FOV: 45 degrees:
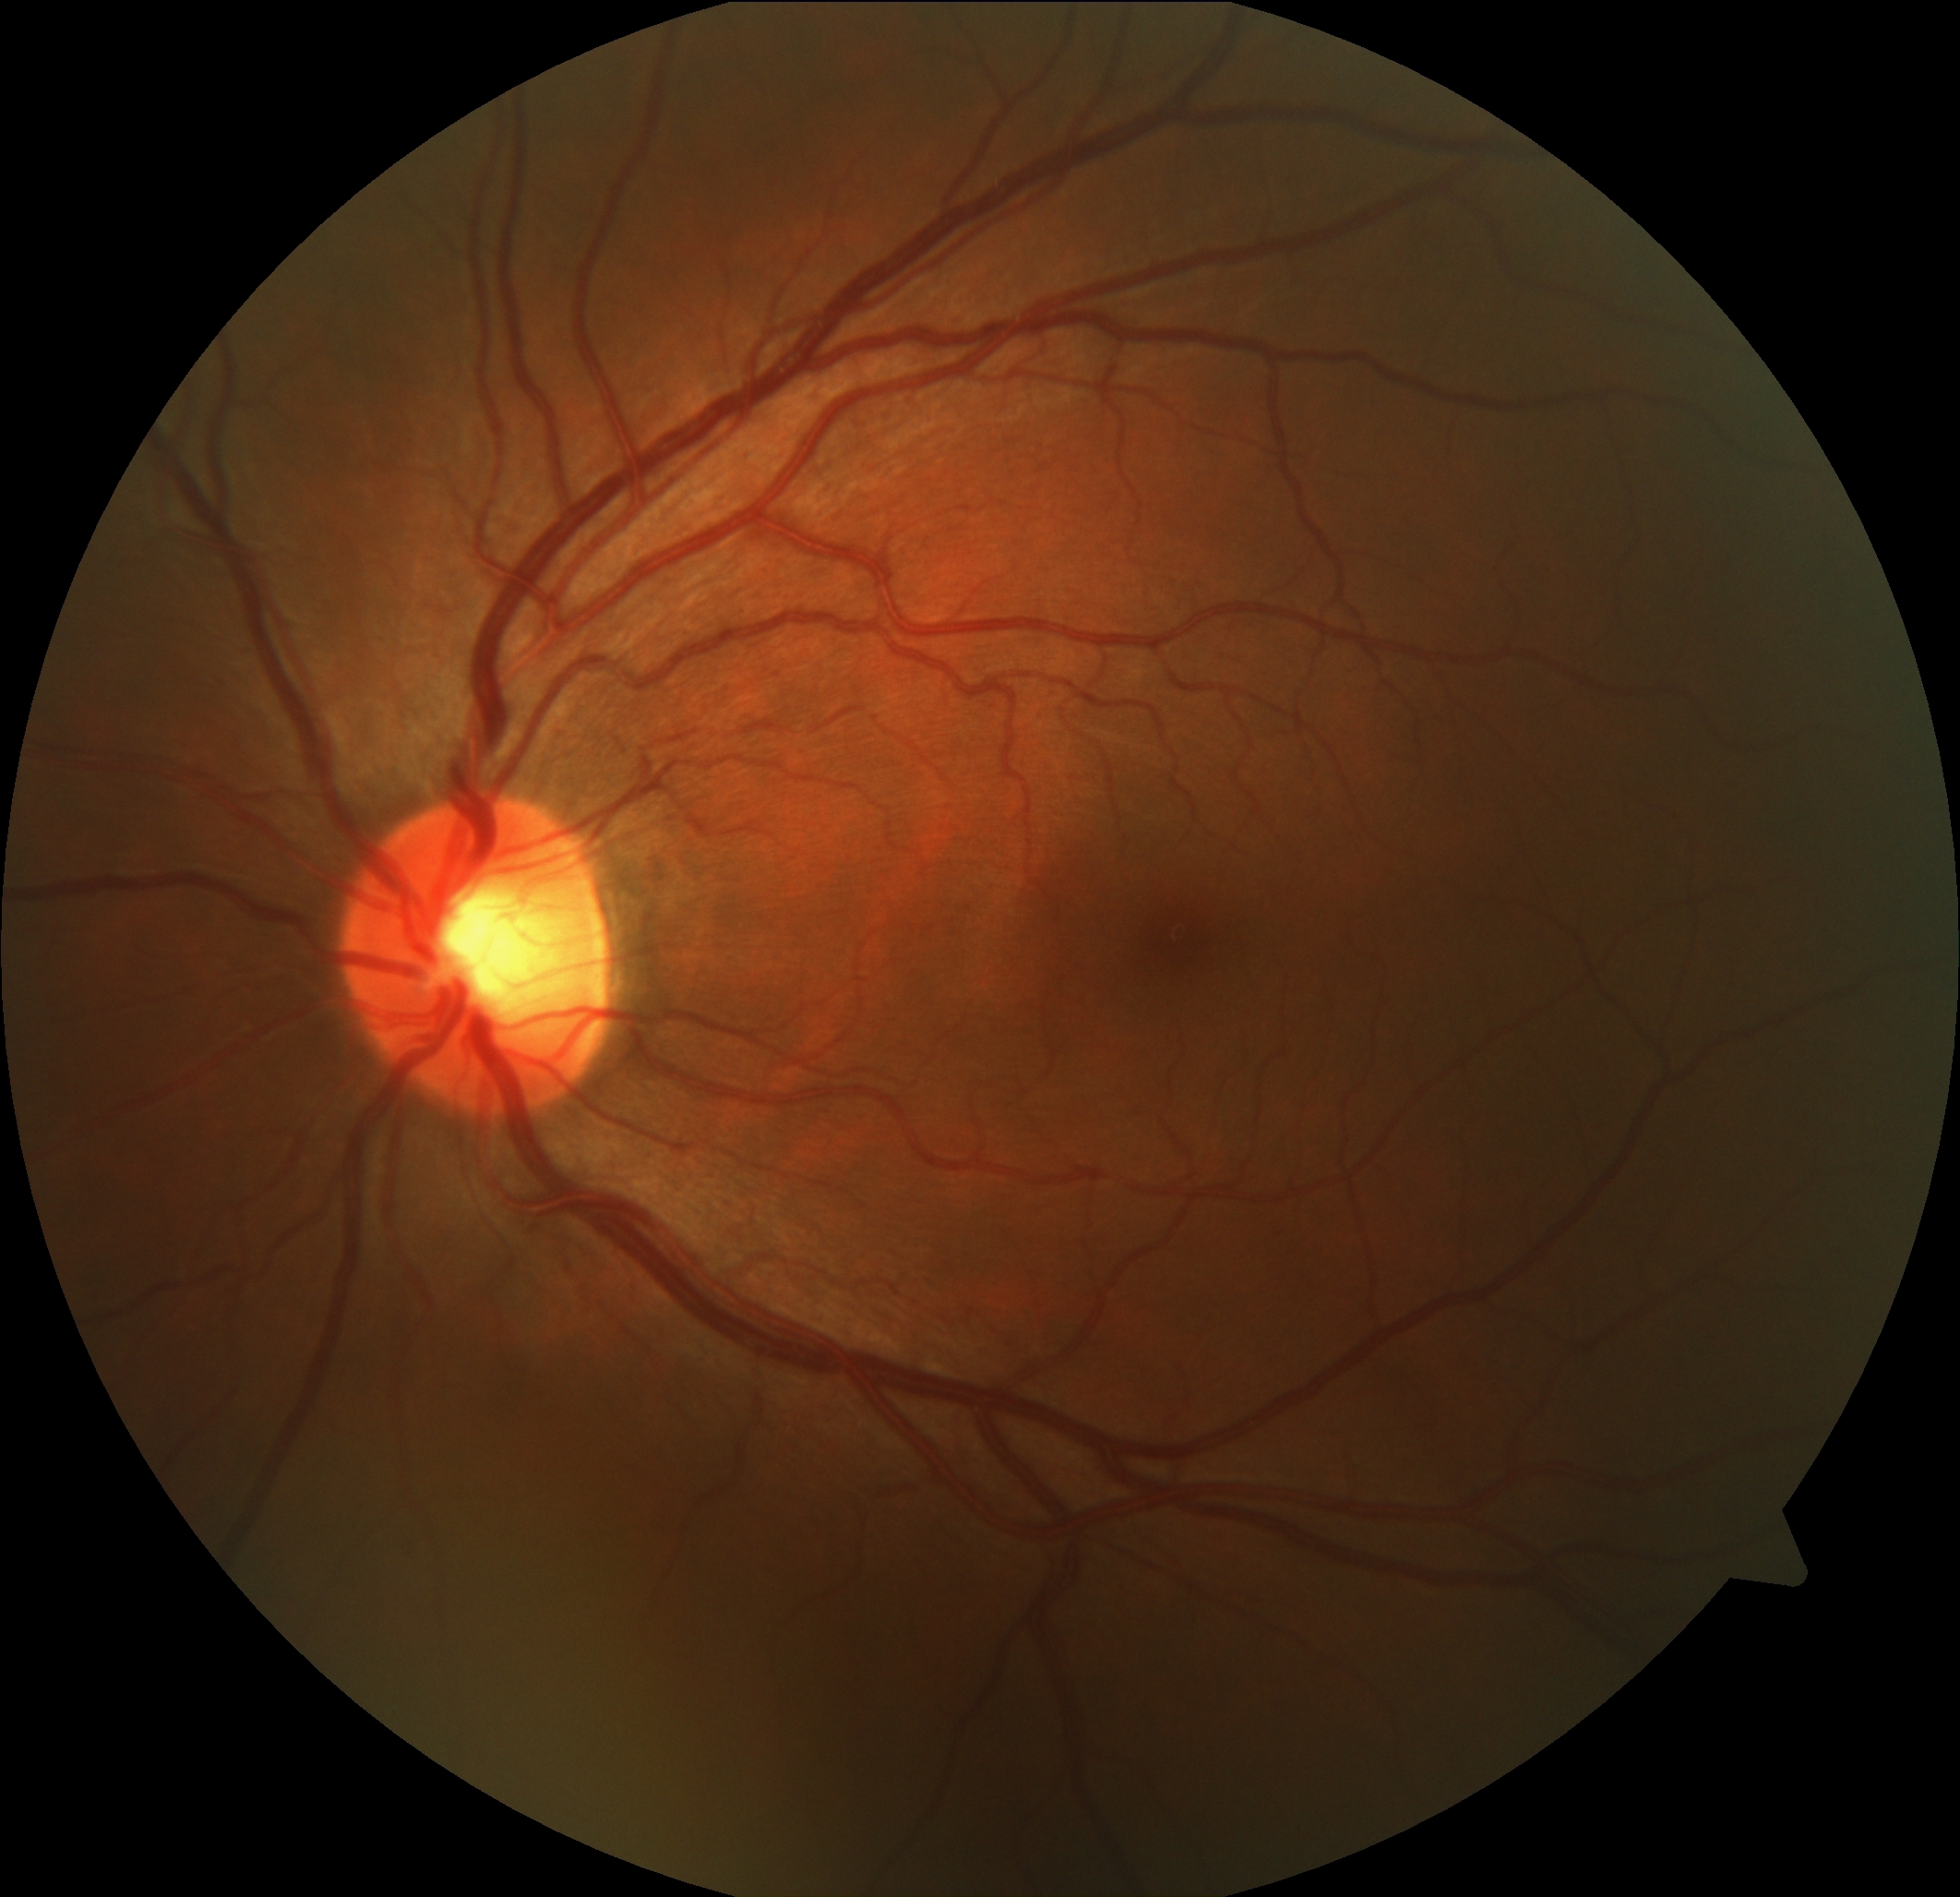 Findings:
• retinopathy grade — 0/4 — no visible signs of diabetic retinopathy